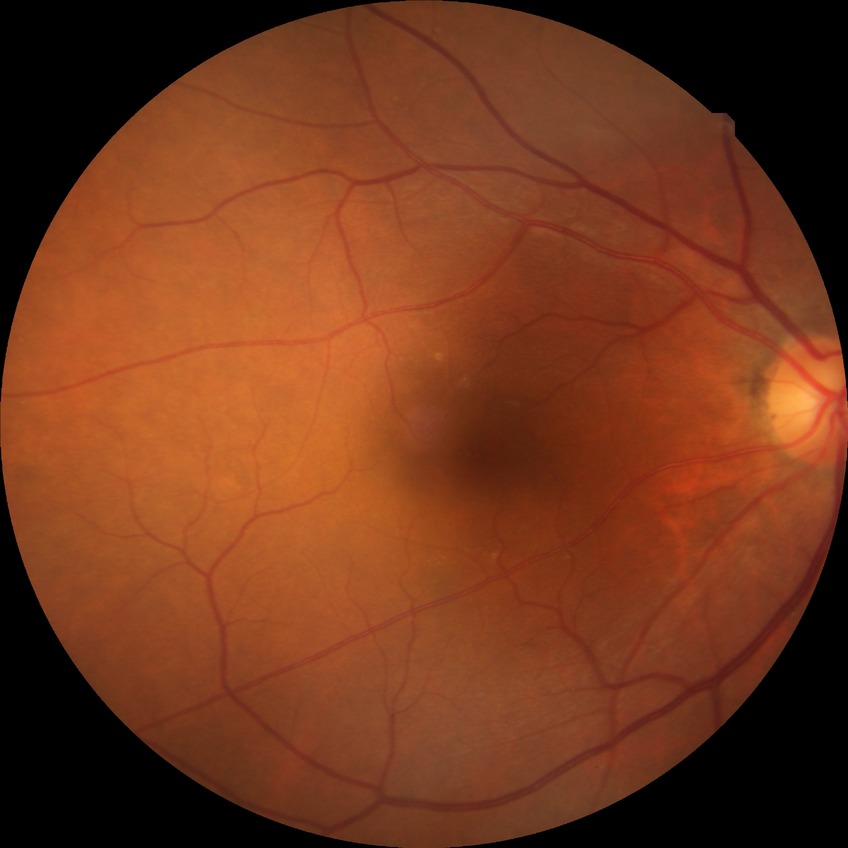 diabetic retinopathy (DR)@no diabetic retinopathy (NDR).